Wide-field contact fundus photograph of an infant; 1240x1240 — 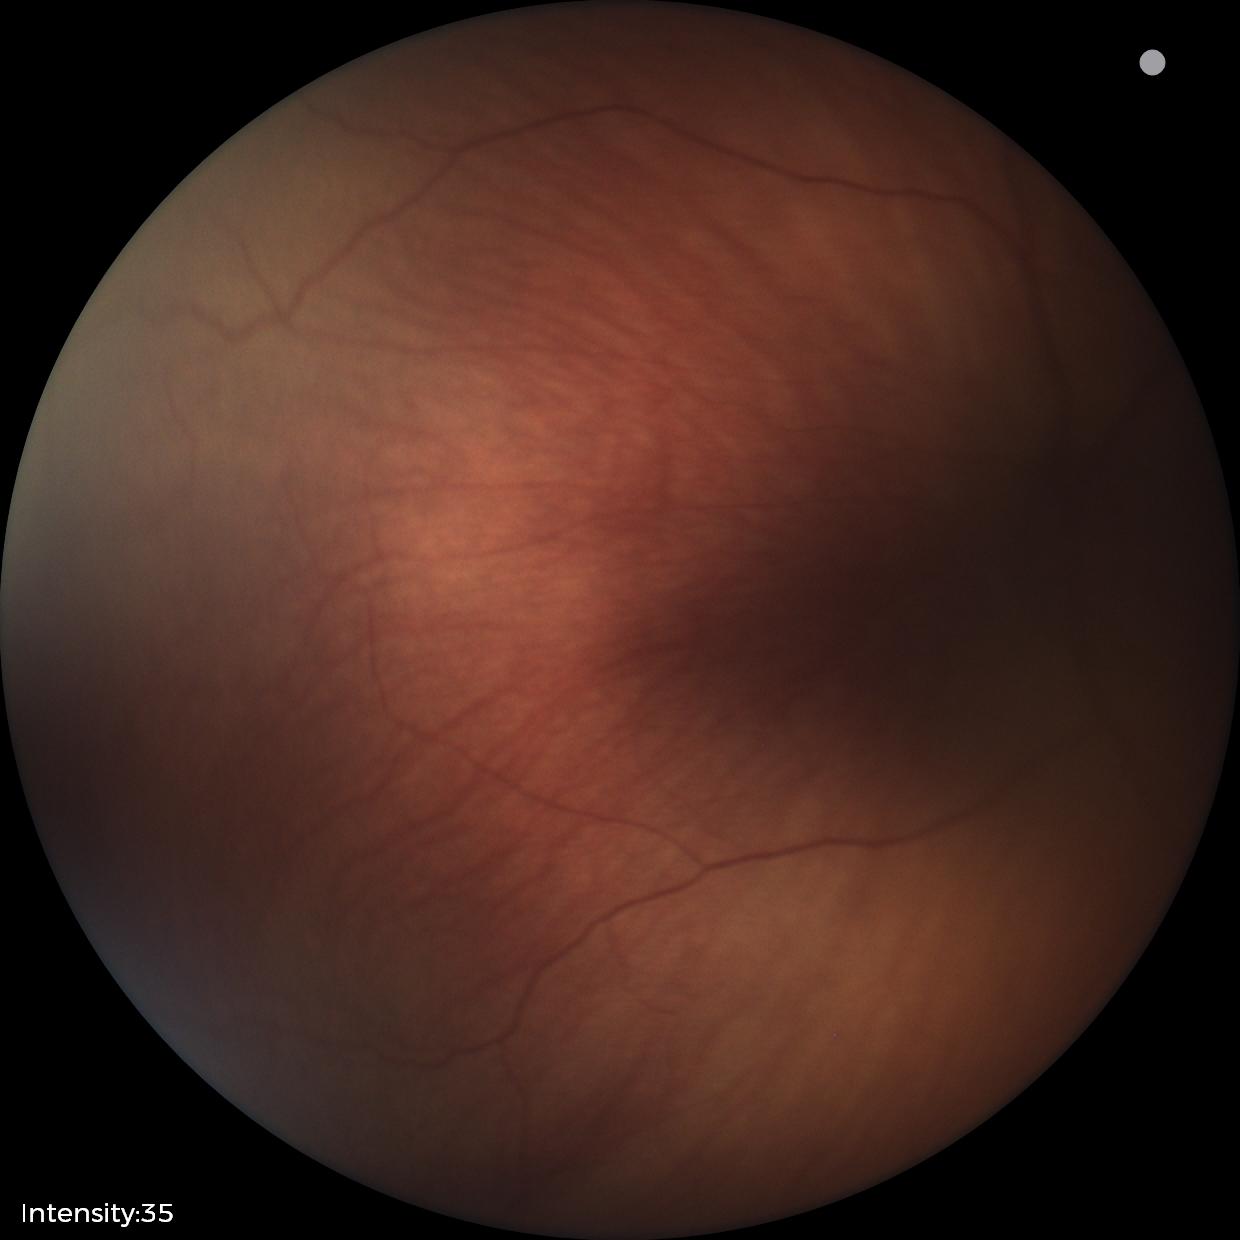
From an examination with diagnosis of retinopathy of prematurity stage 2. No plus disease.